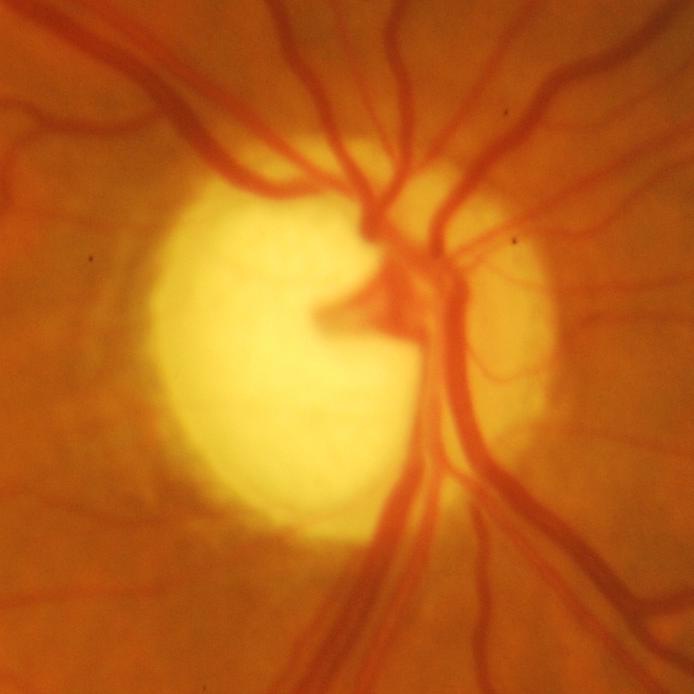
The image shows glaucomatous findings.